50° FOV · captured after pupil dilation · field includes the optic disc and macula
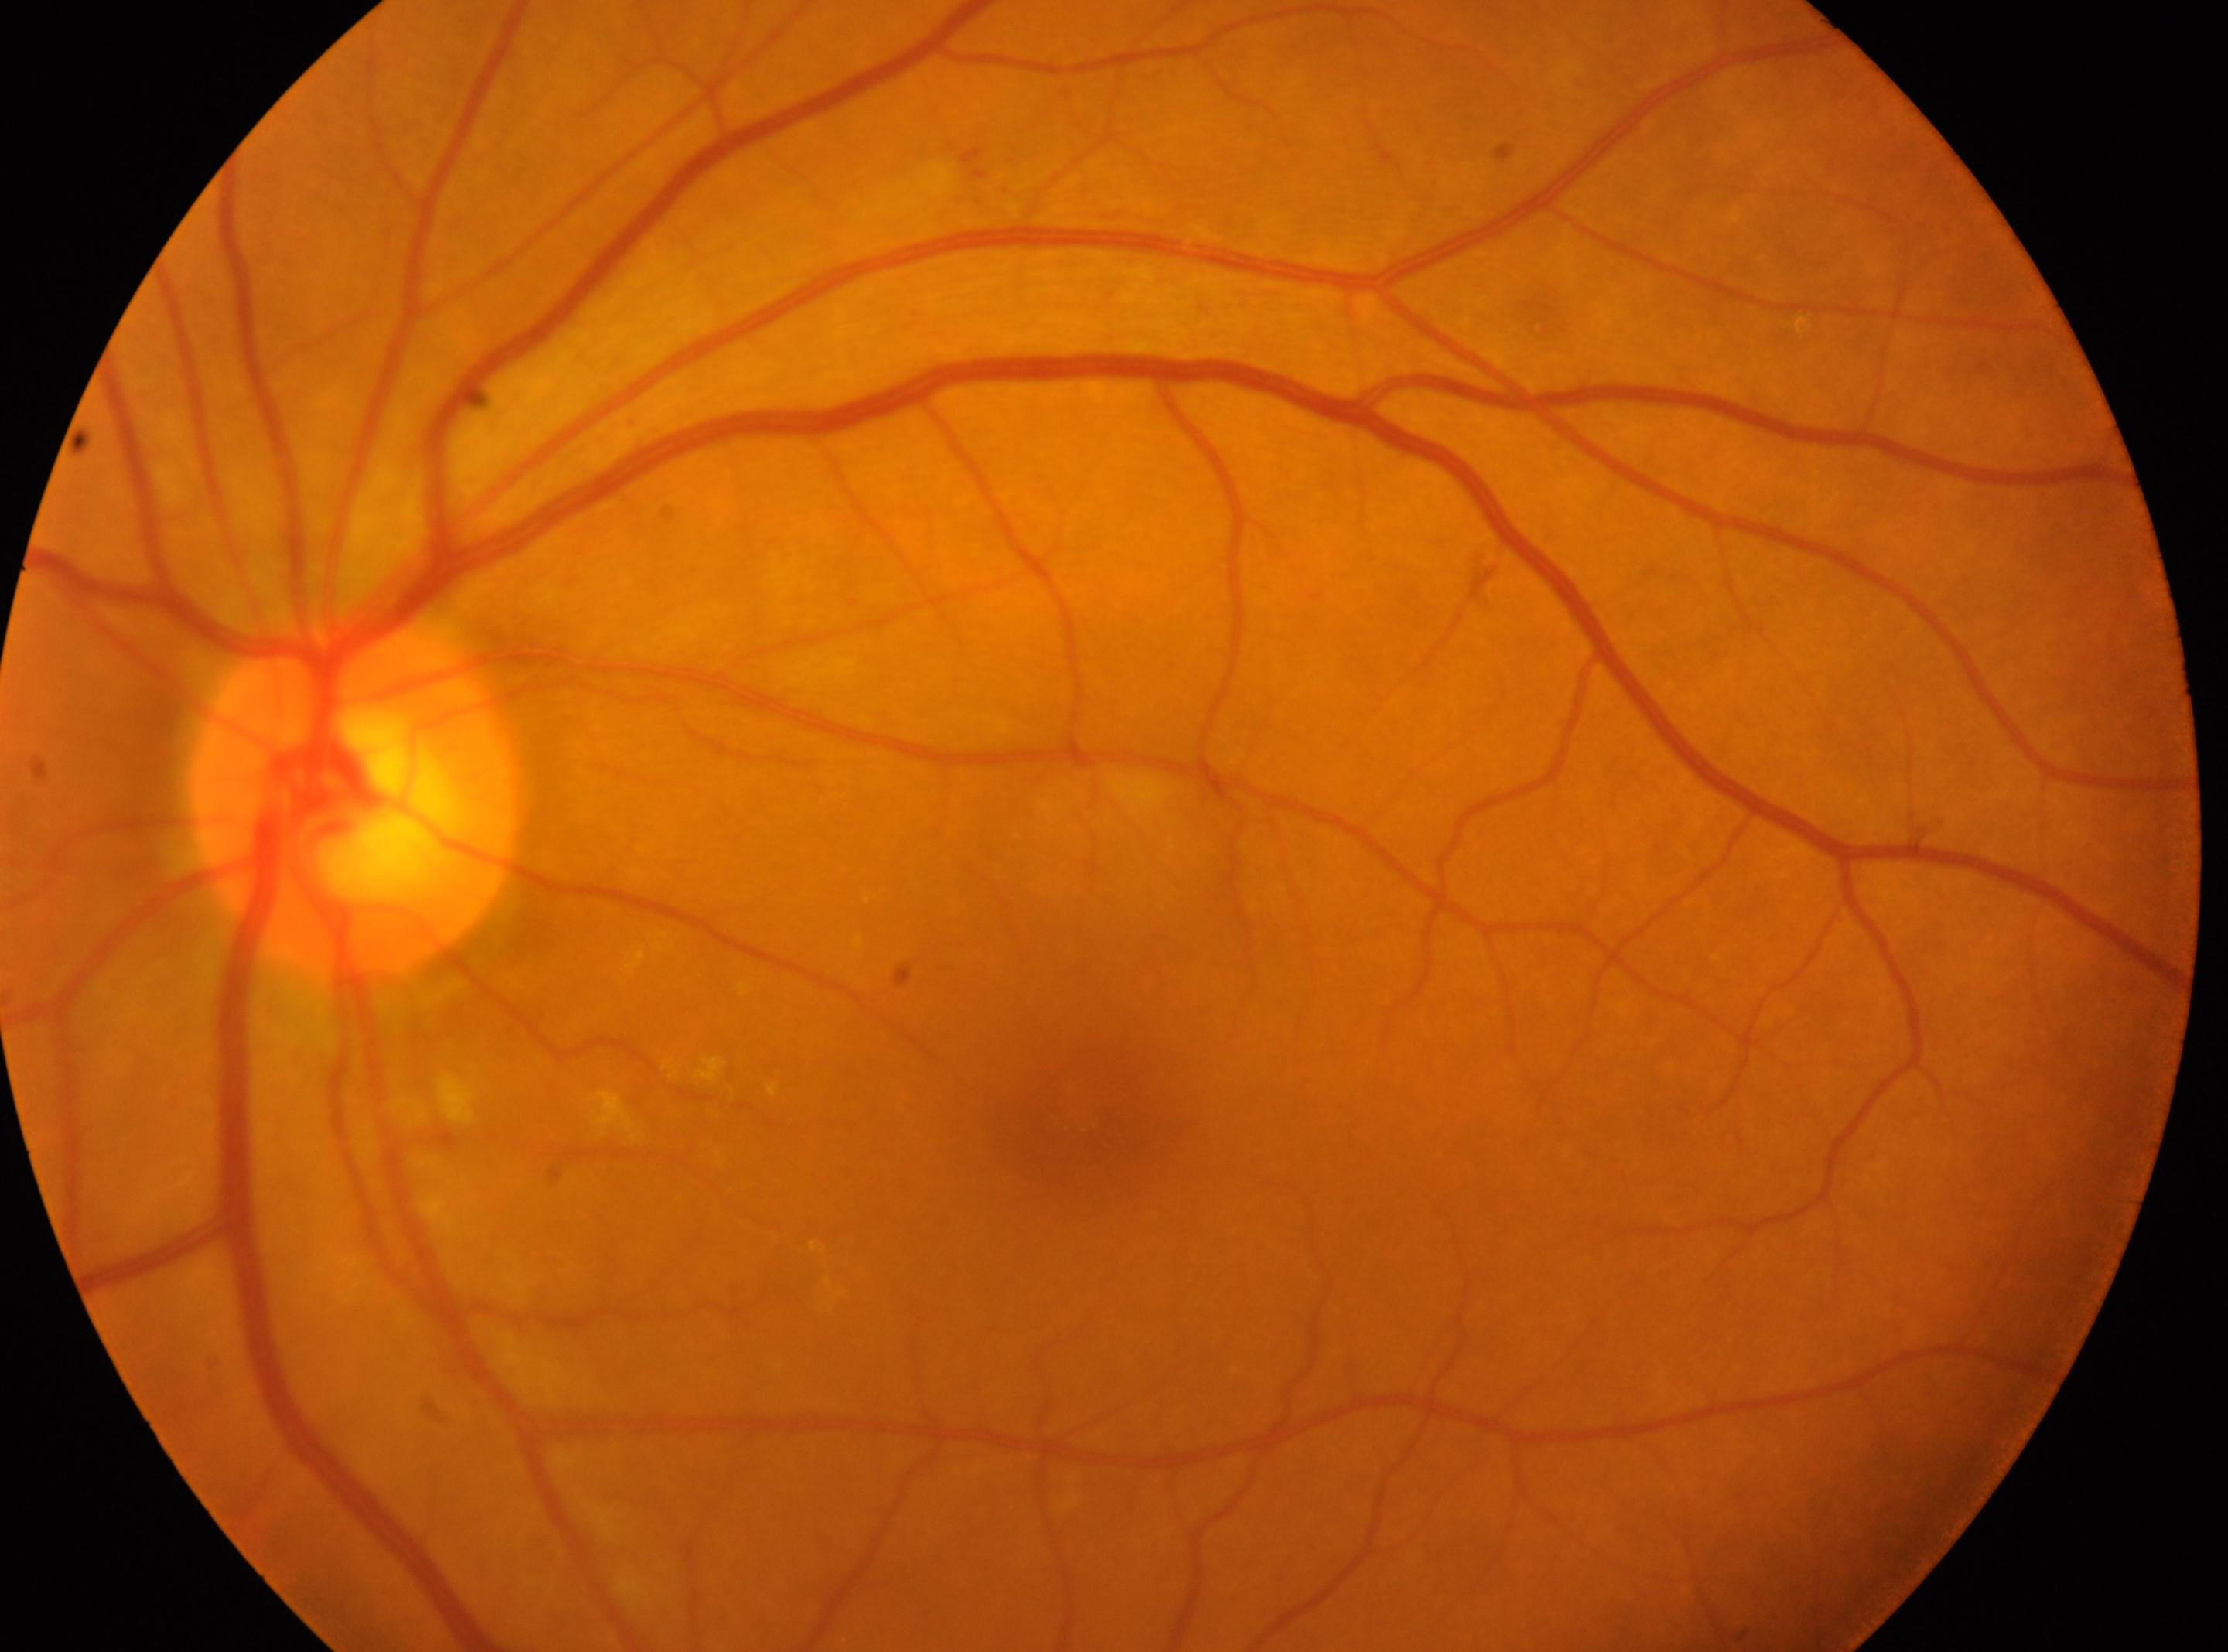 diabetic retinopathy = 2/4 — more than just microaneurysms but less than severe NPDR | eye = OS | macula center = 1085px, 1125px | disc center = 355px, 797px.